Image size 640x480. 130° field of view (Clarity RetCam 3). Wide-field fundus photograph from neonatal ROP screening — 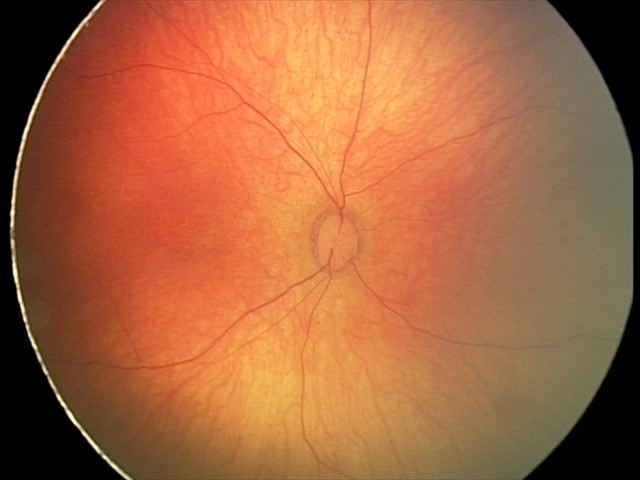

Screening: physiological retinal finding.